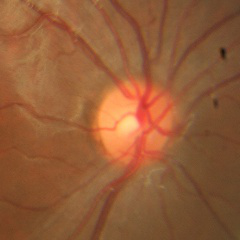 No signs of glaucoma.